Infant wide-field retinal image:
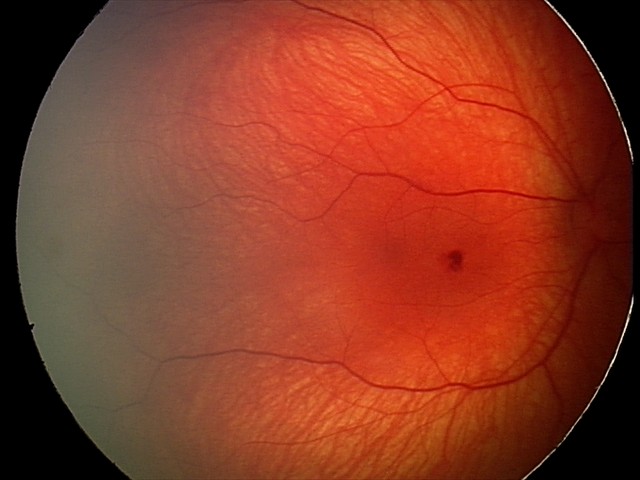

Finding = retinal hemorrhages.